Wide-field contact fundus photograph of an infant
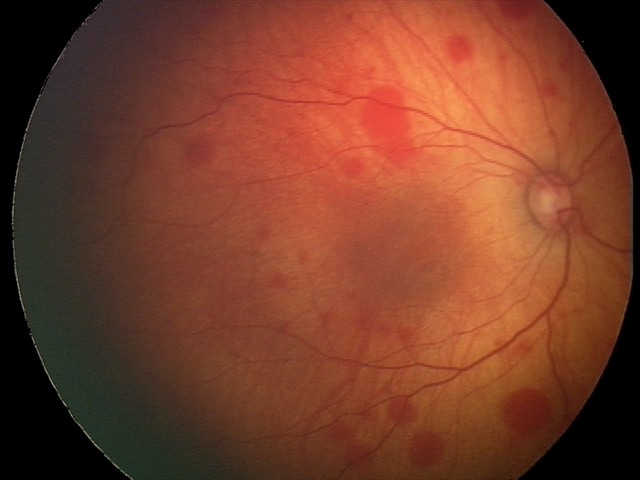
Assessment = retinal hemorrhages